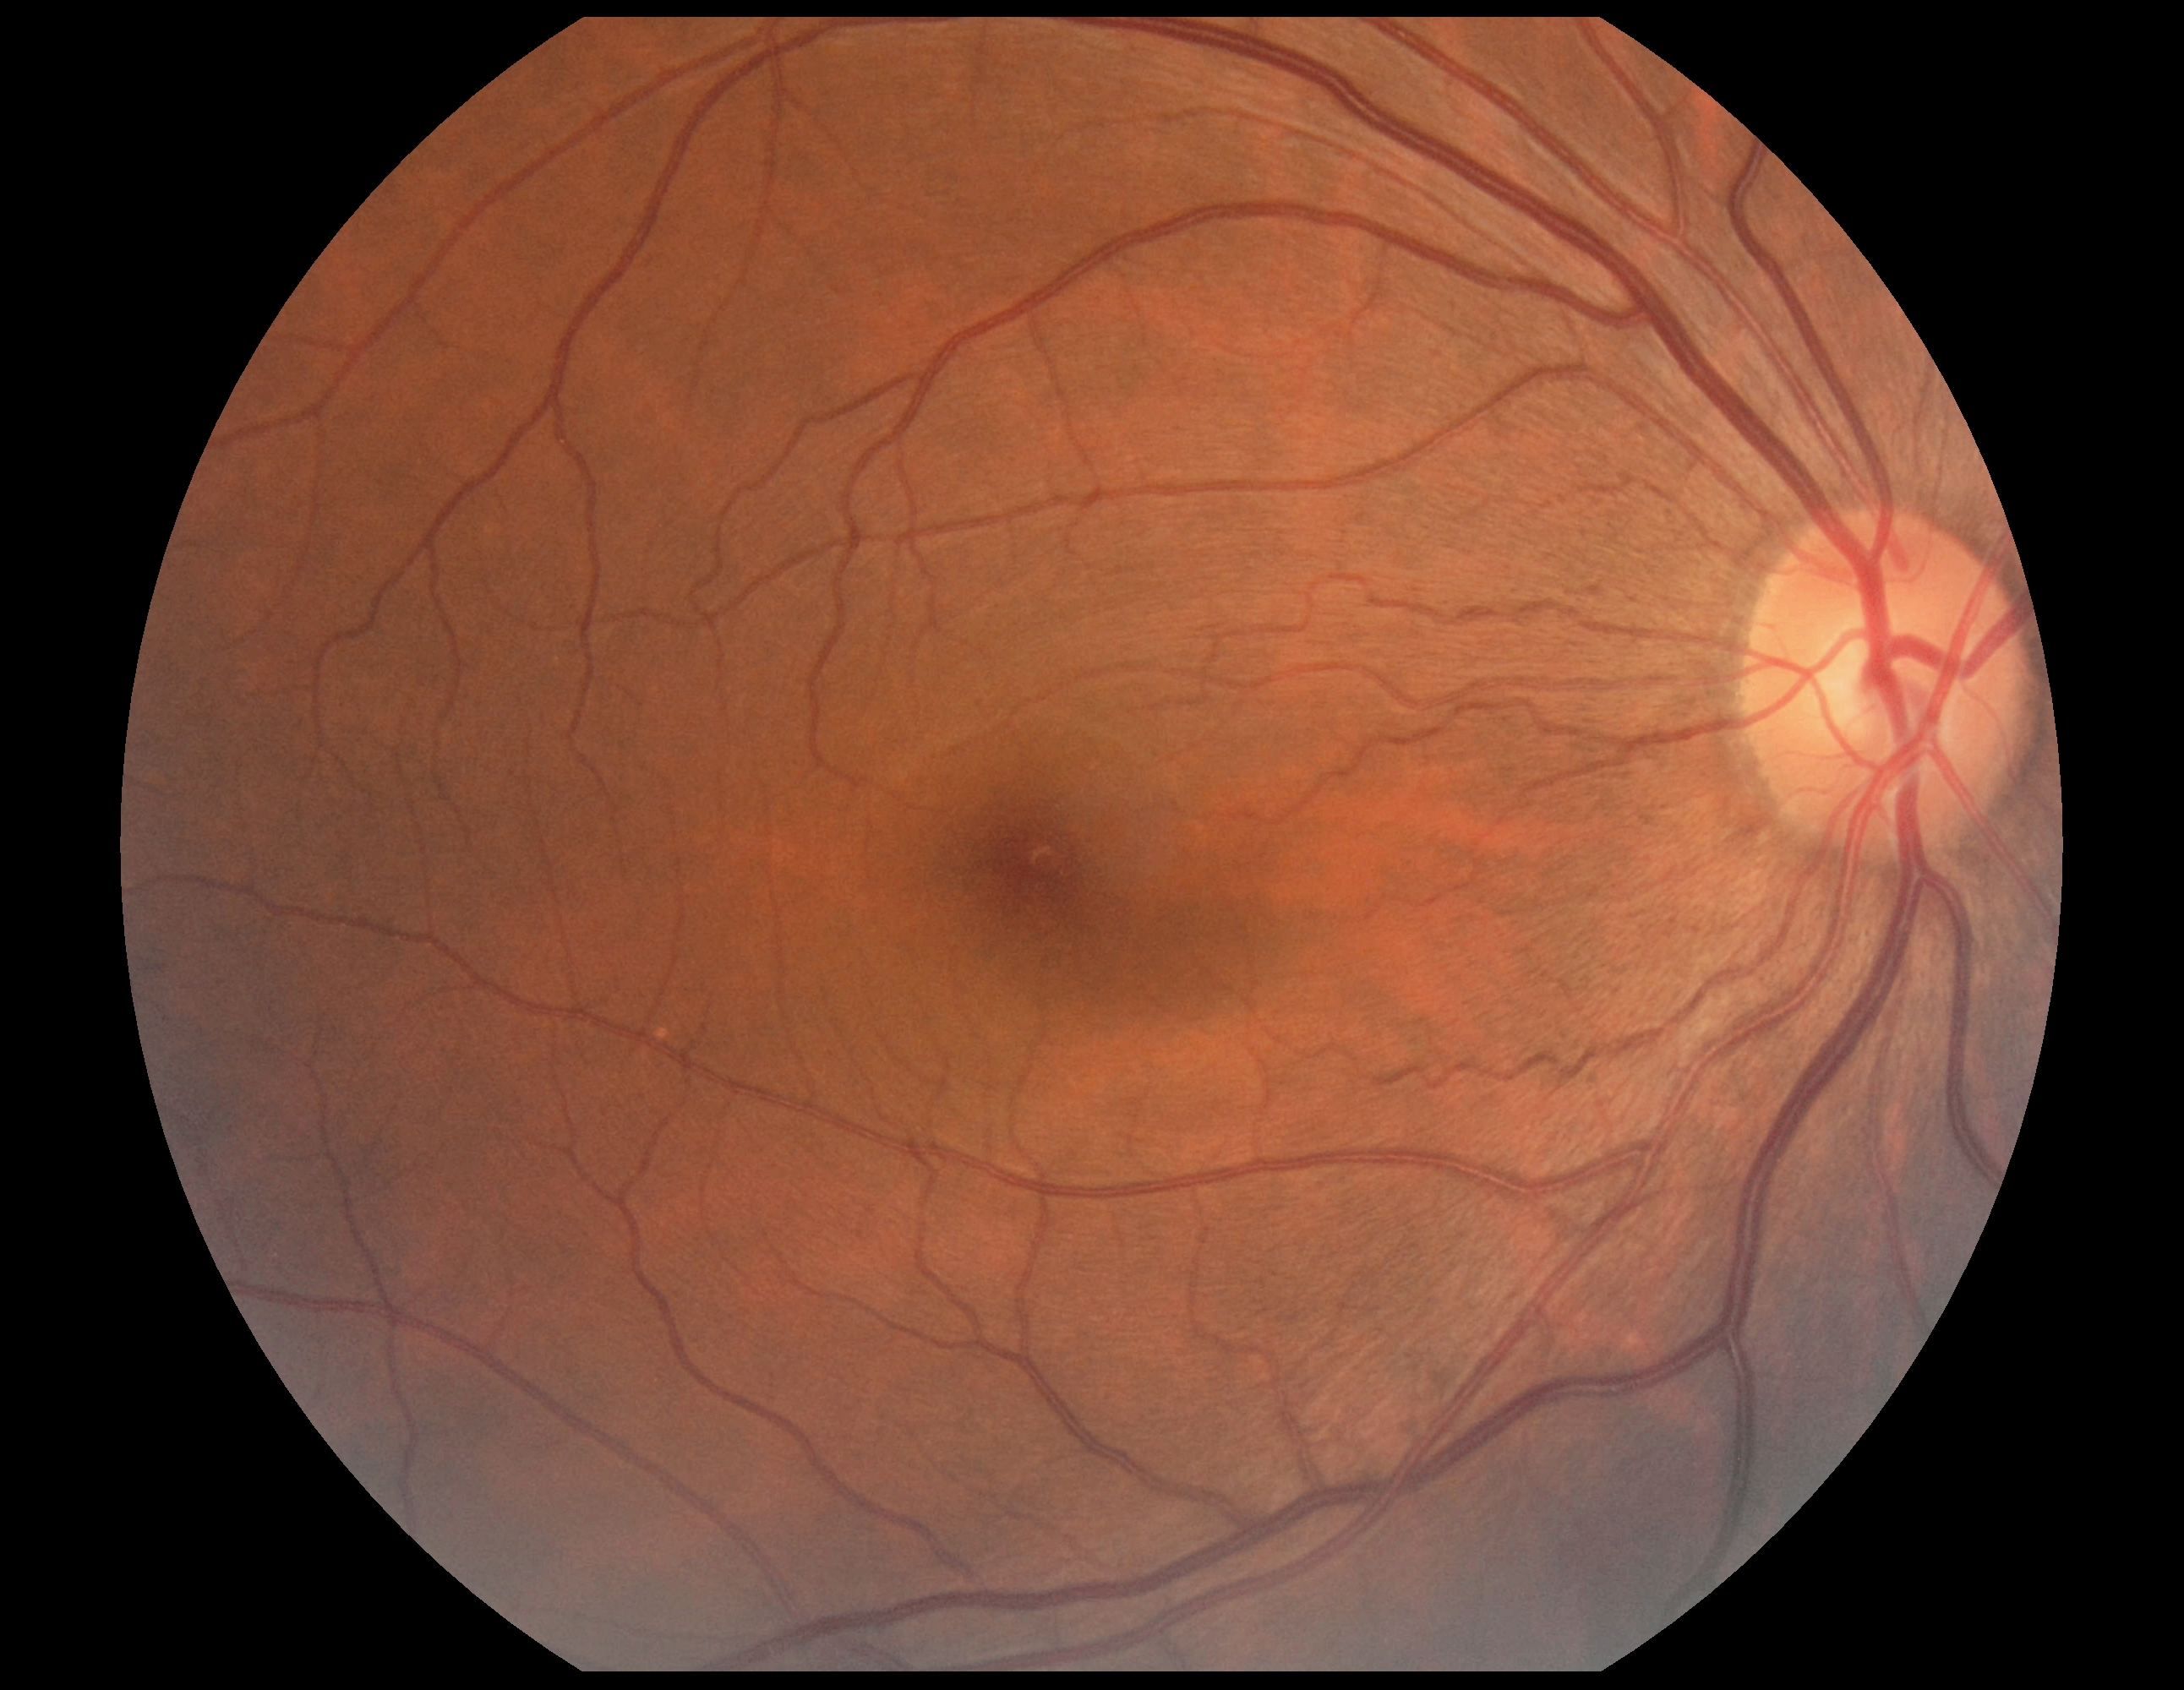 diabetic retinopathy: grade 0.